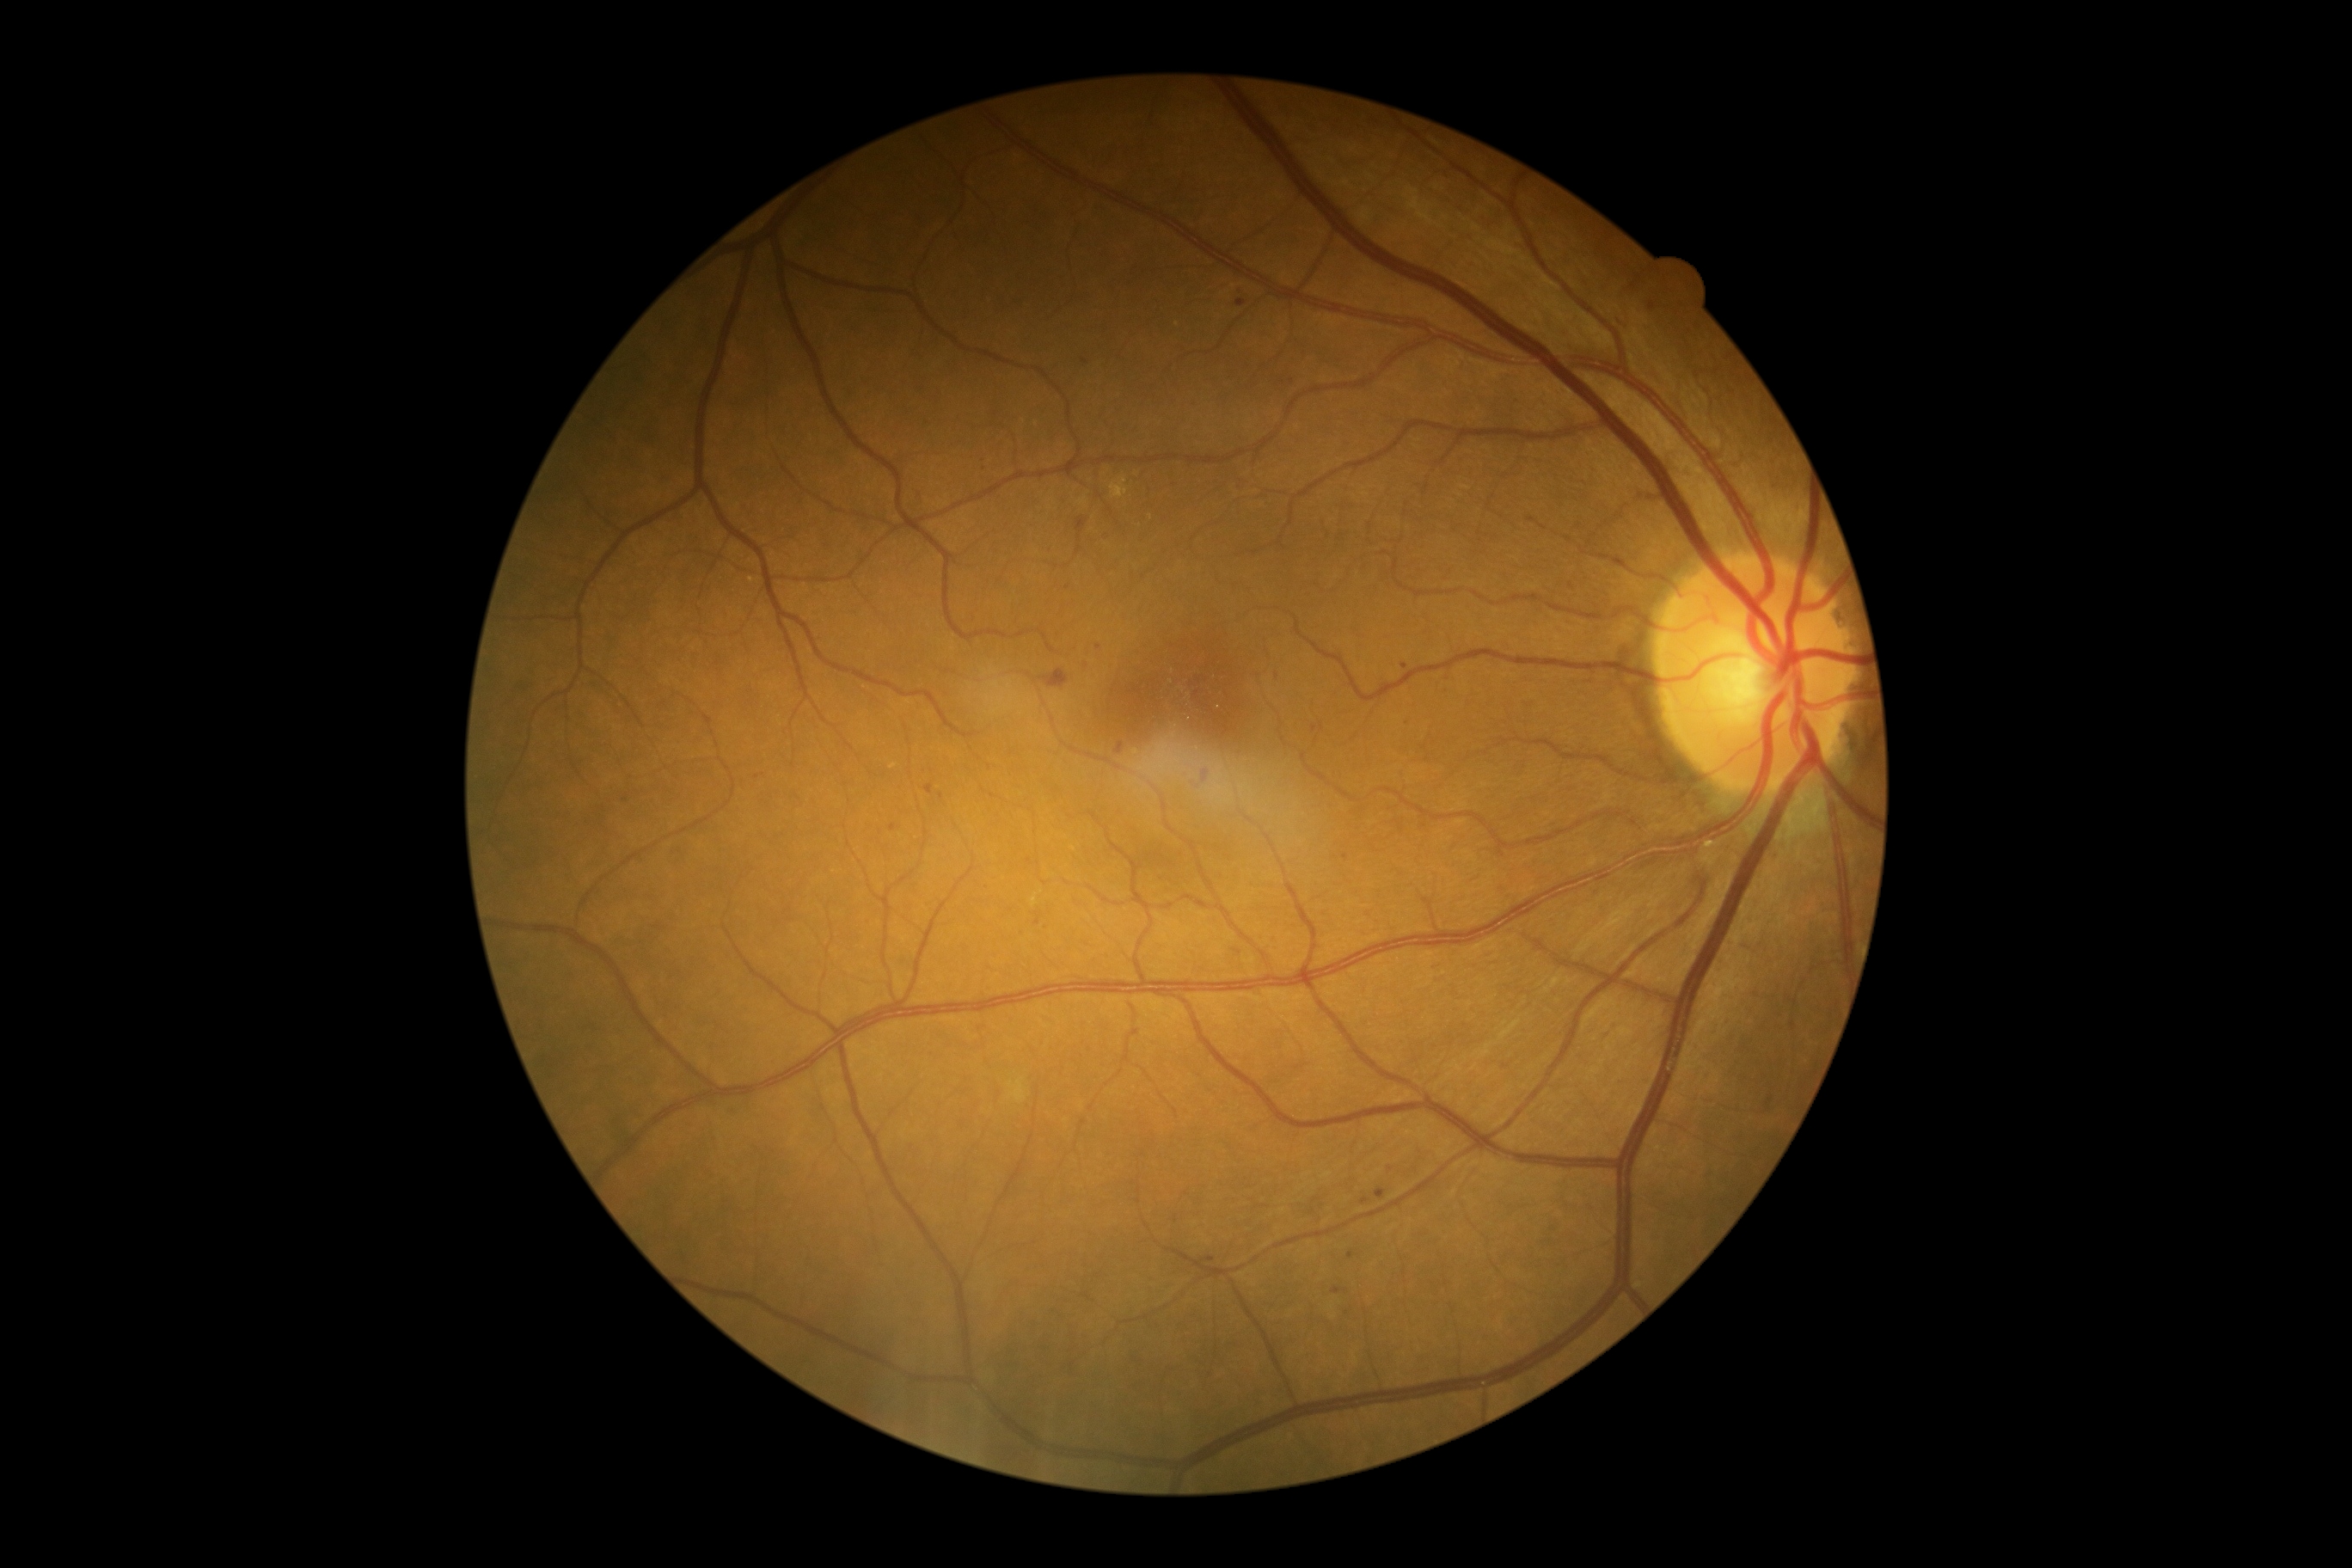

diabetic retinopathy (DR)@grade 2; DR class@non-proliferative diabetic retinopathy.